45° FOV · color fundus image.
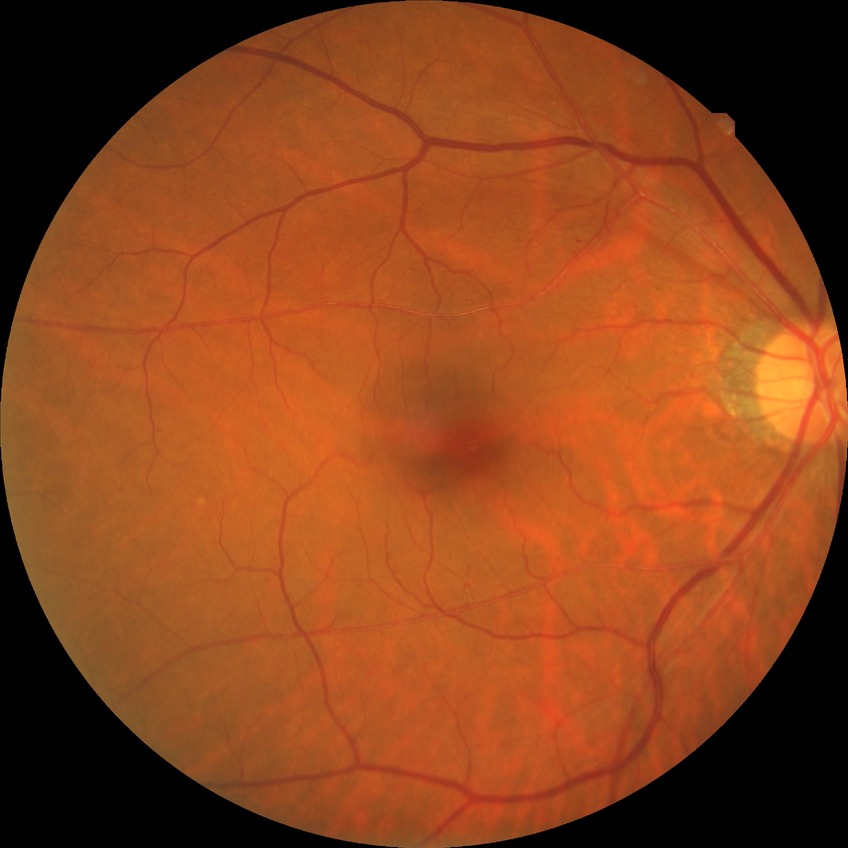
  davis_grade: NDR (no diabetic retinopathy)